Centered on the macula
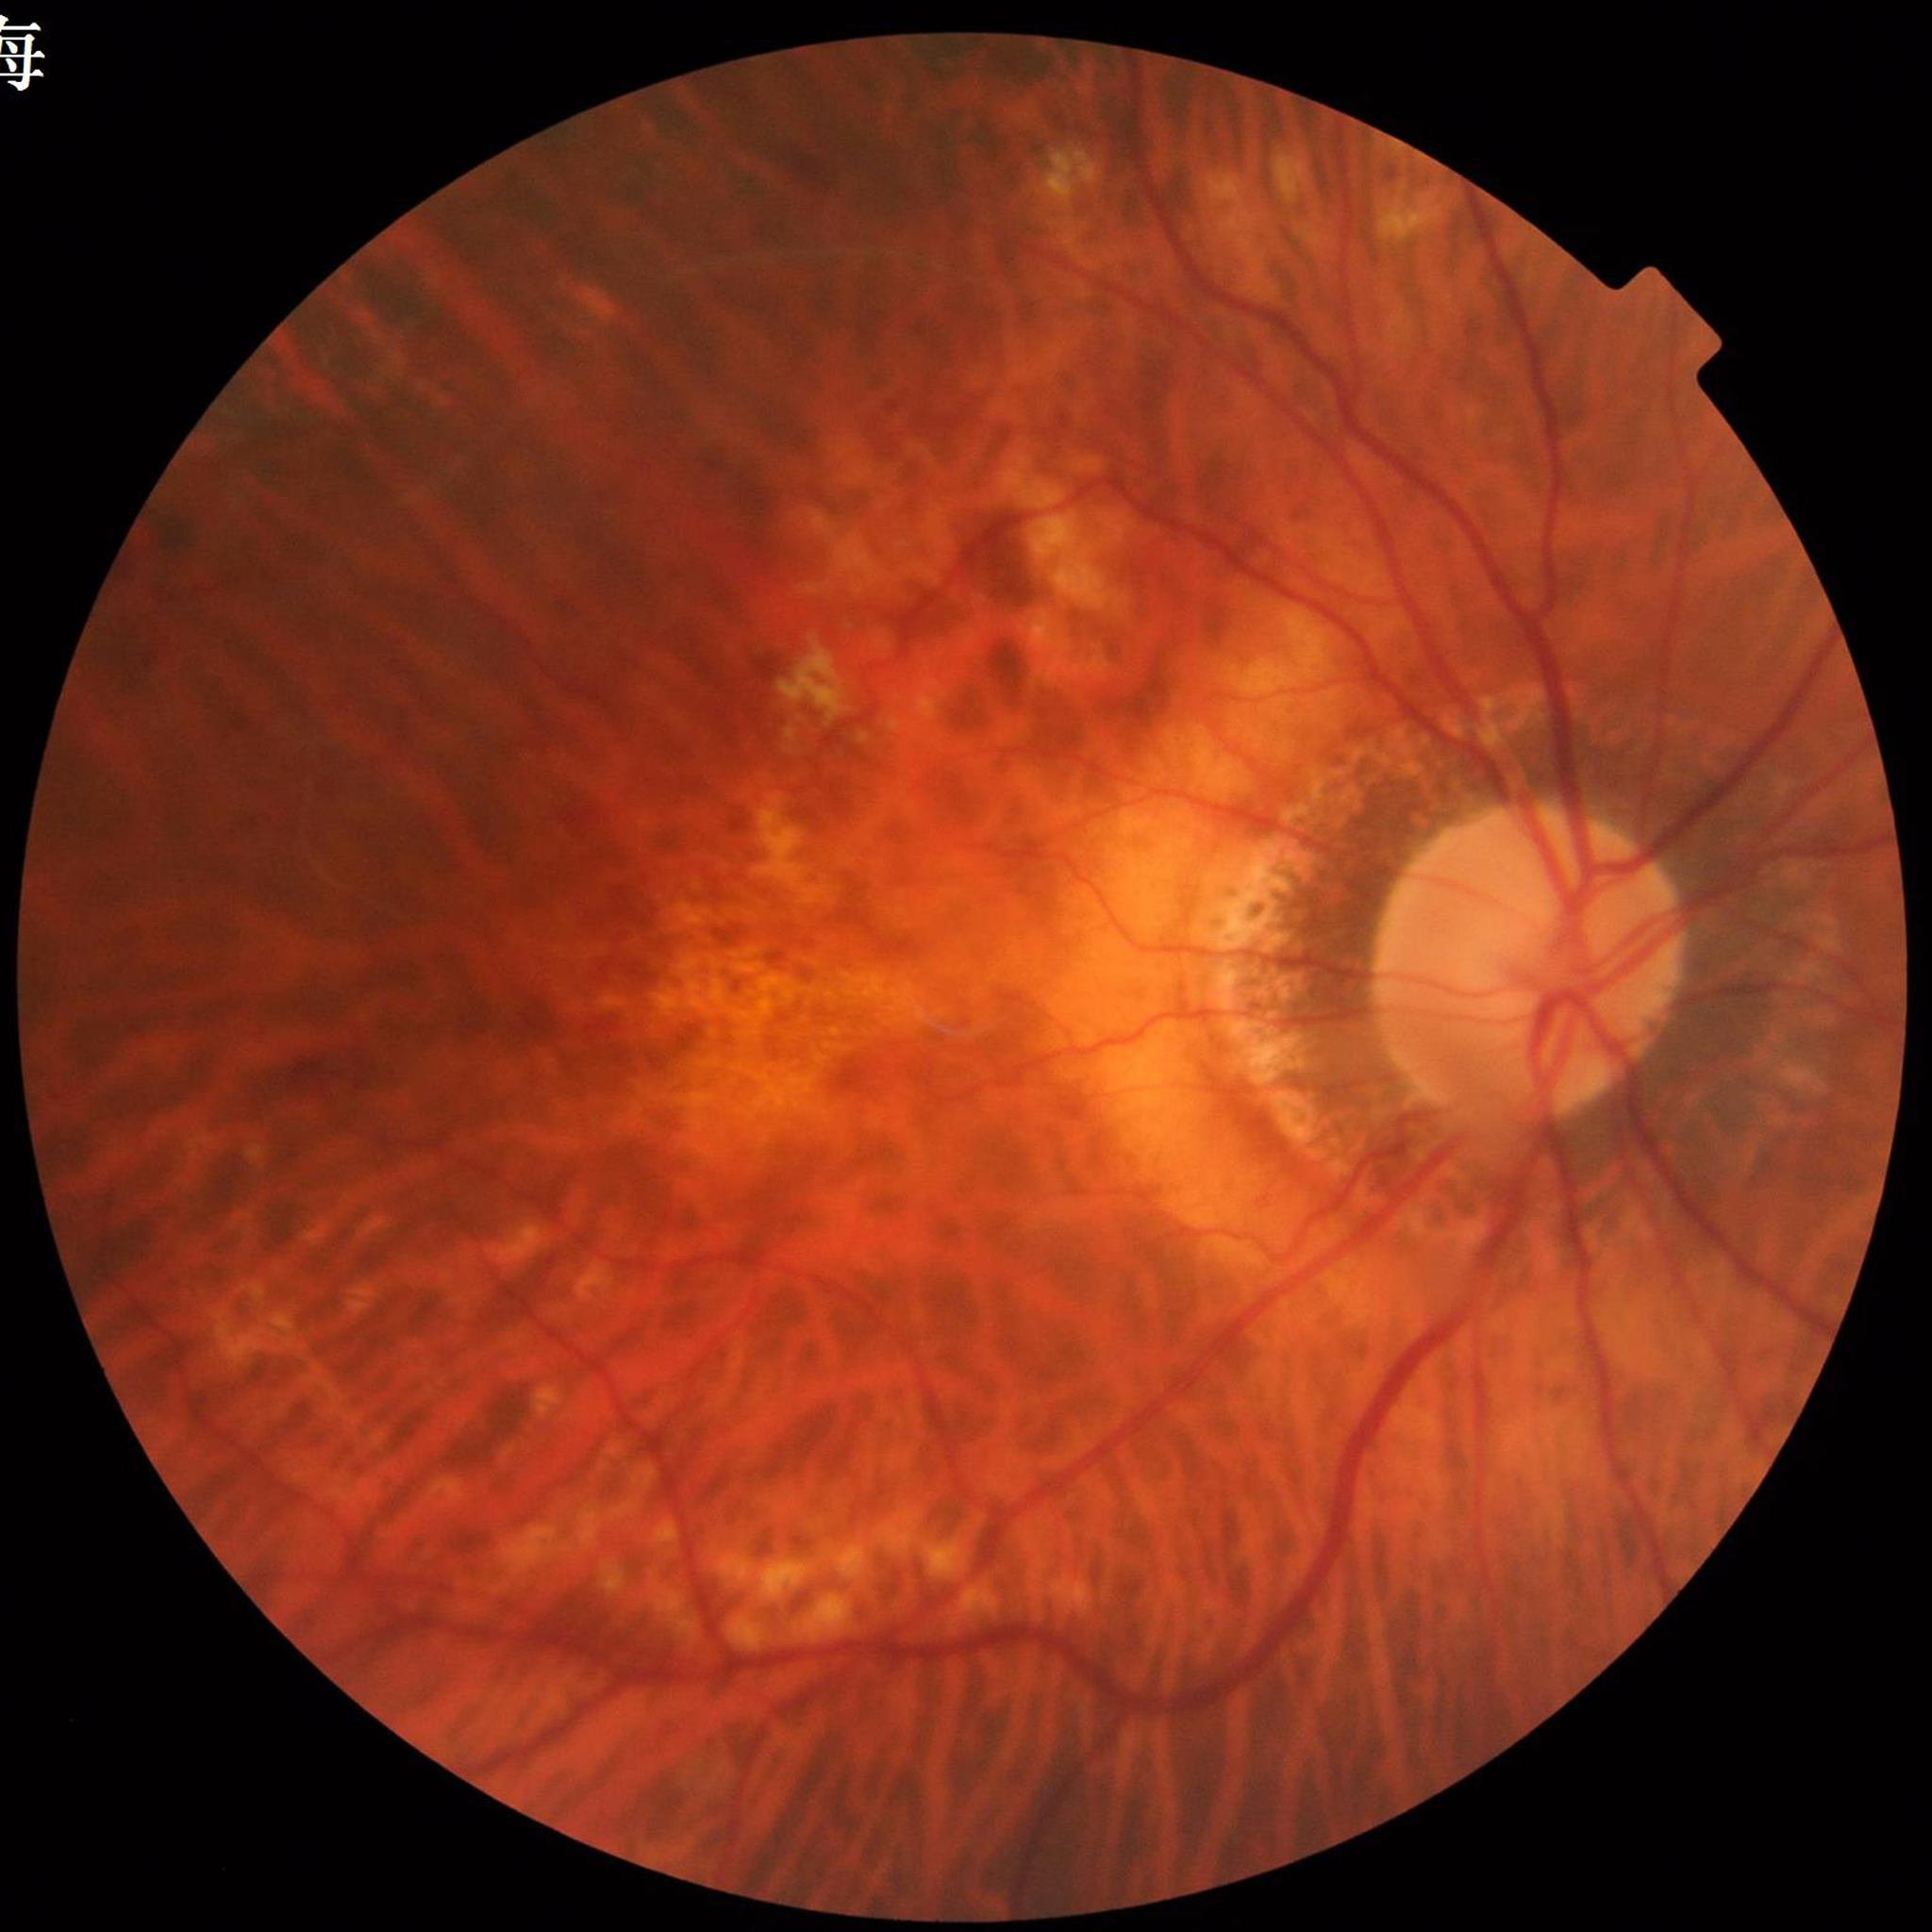
From a patient with AMD.